50° FOV
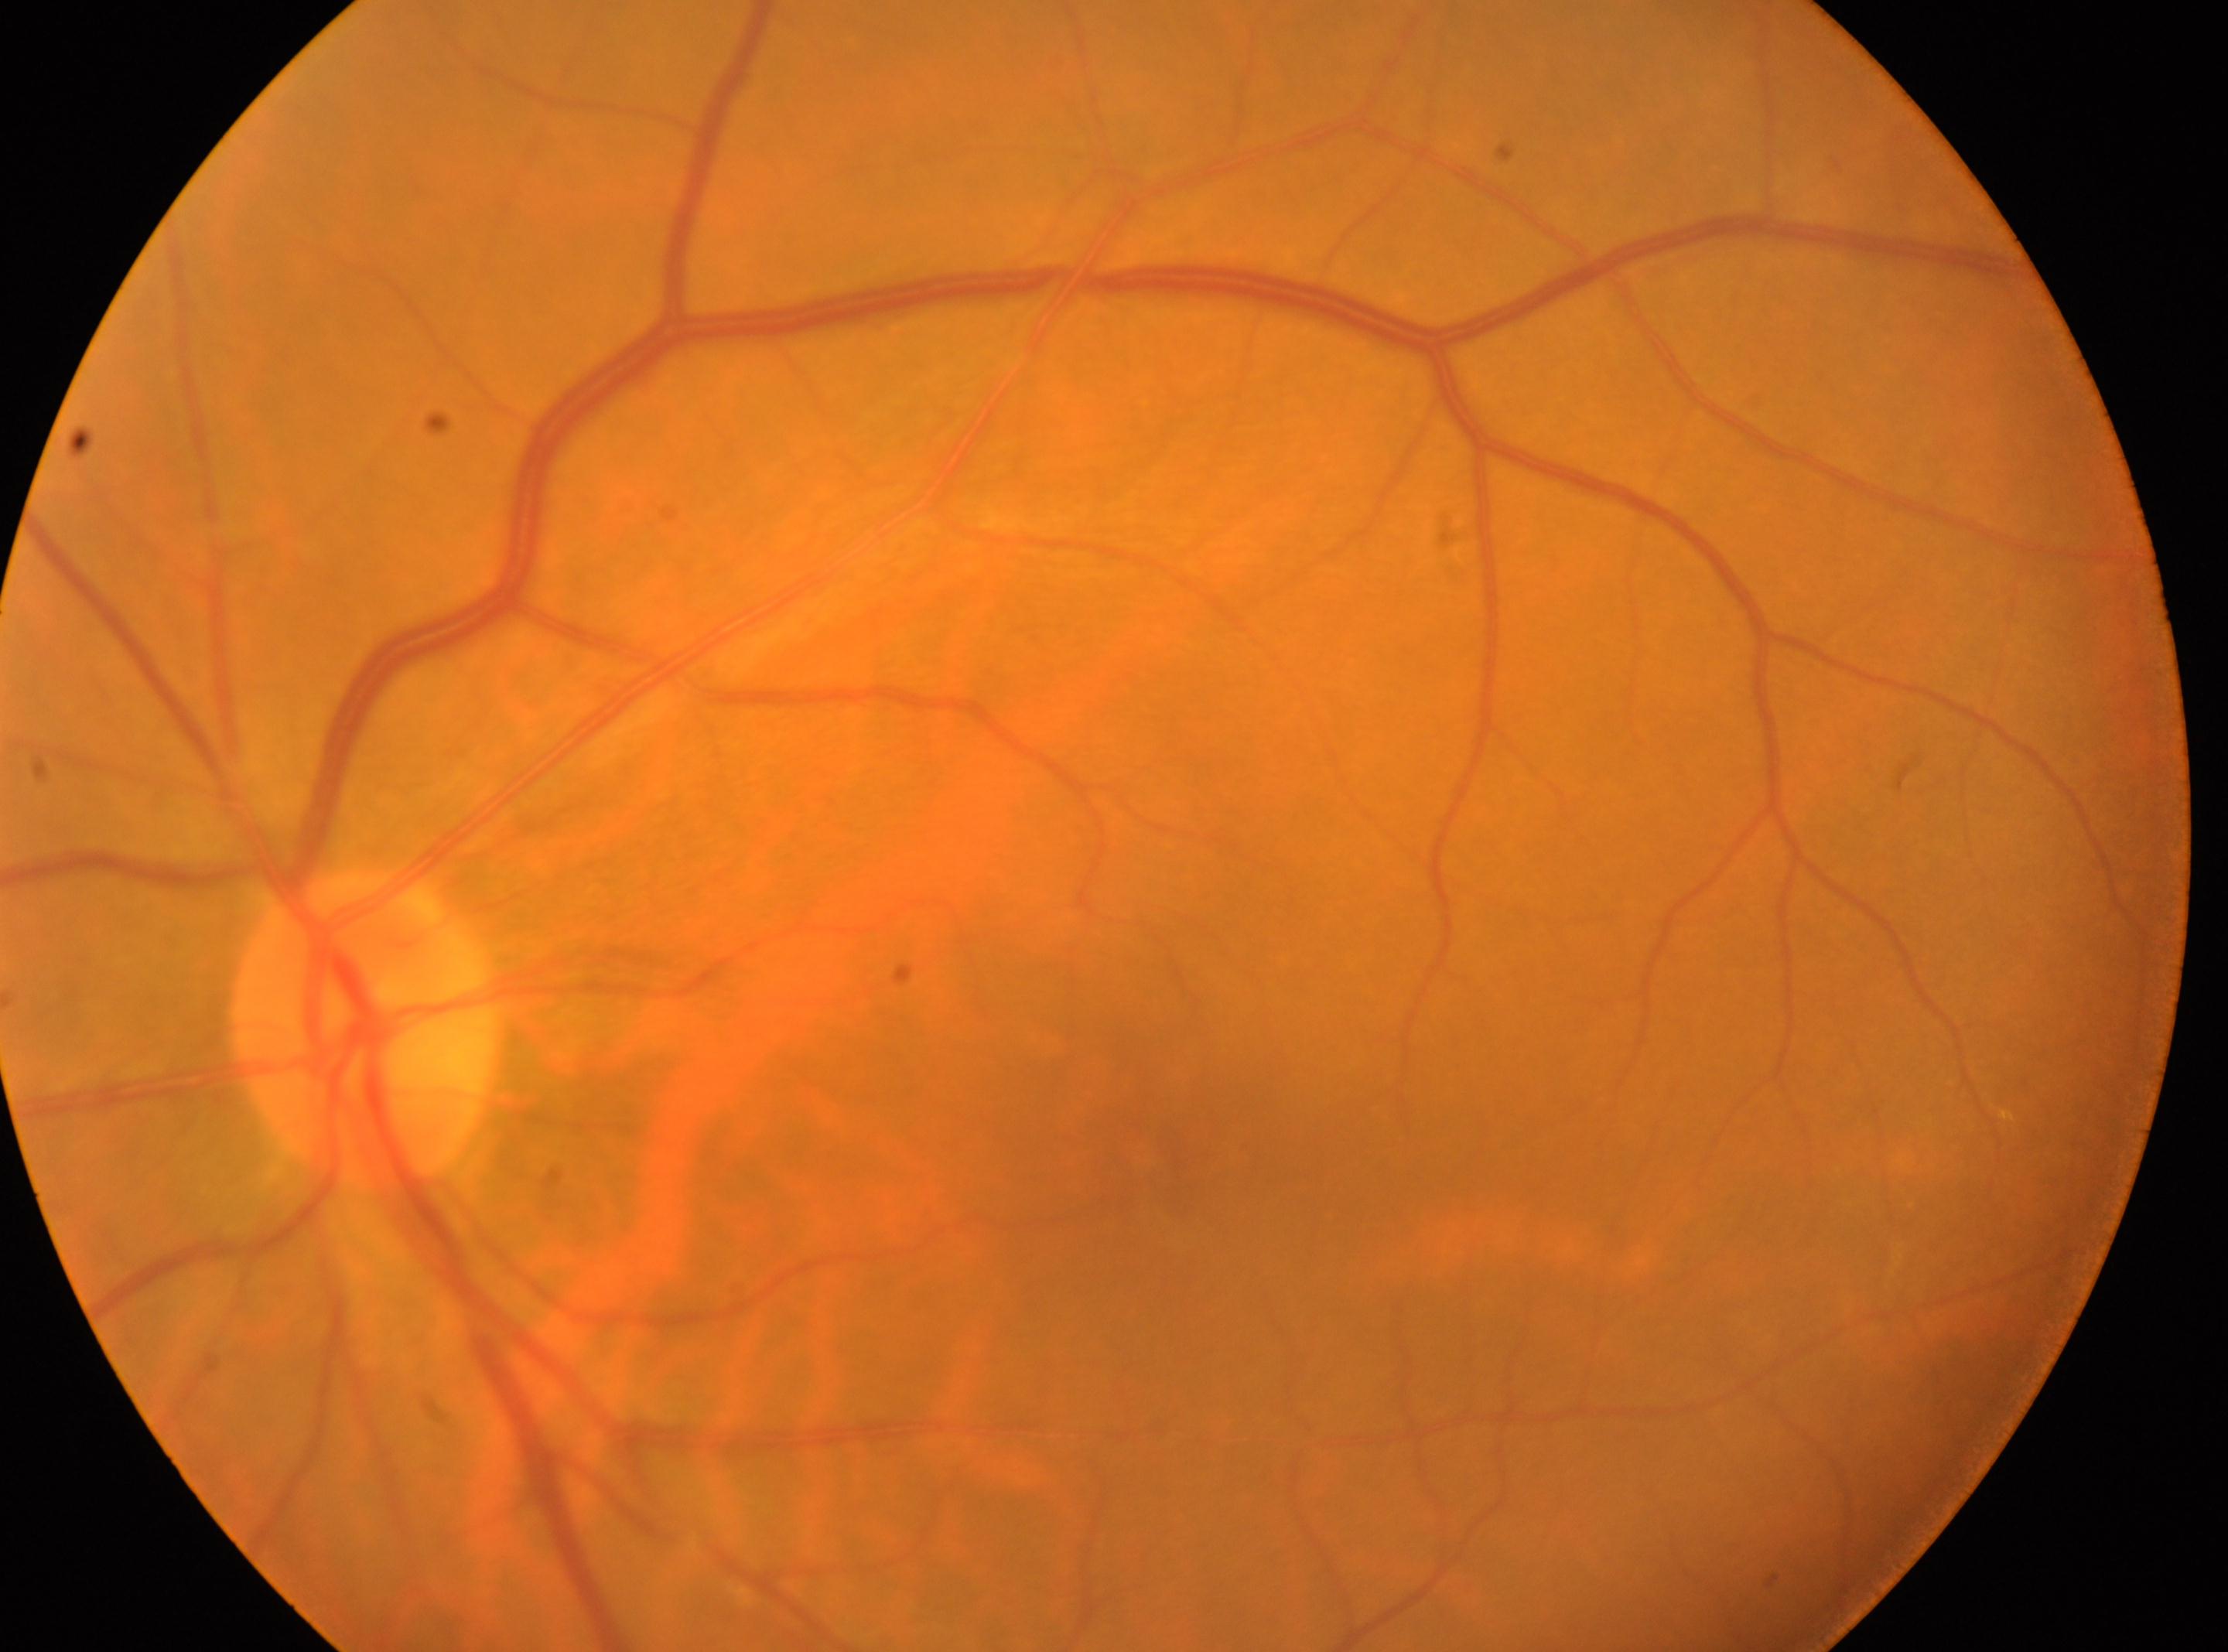 The optic disc is at (362,1029). Fovea center located at (1150,1152). No diabetic retinal disease findings. DR grade: 0 (no apparent retinopathy). Eye: the left eye.